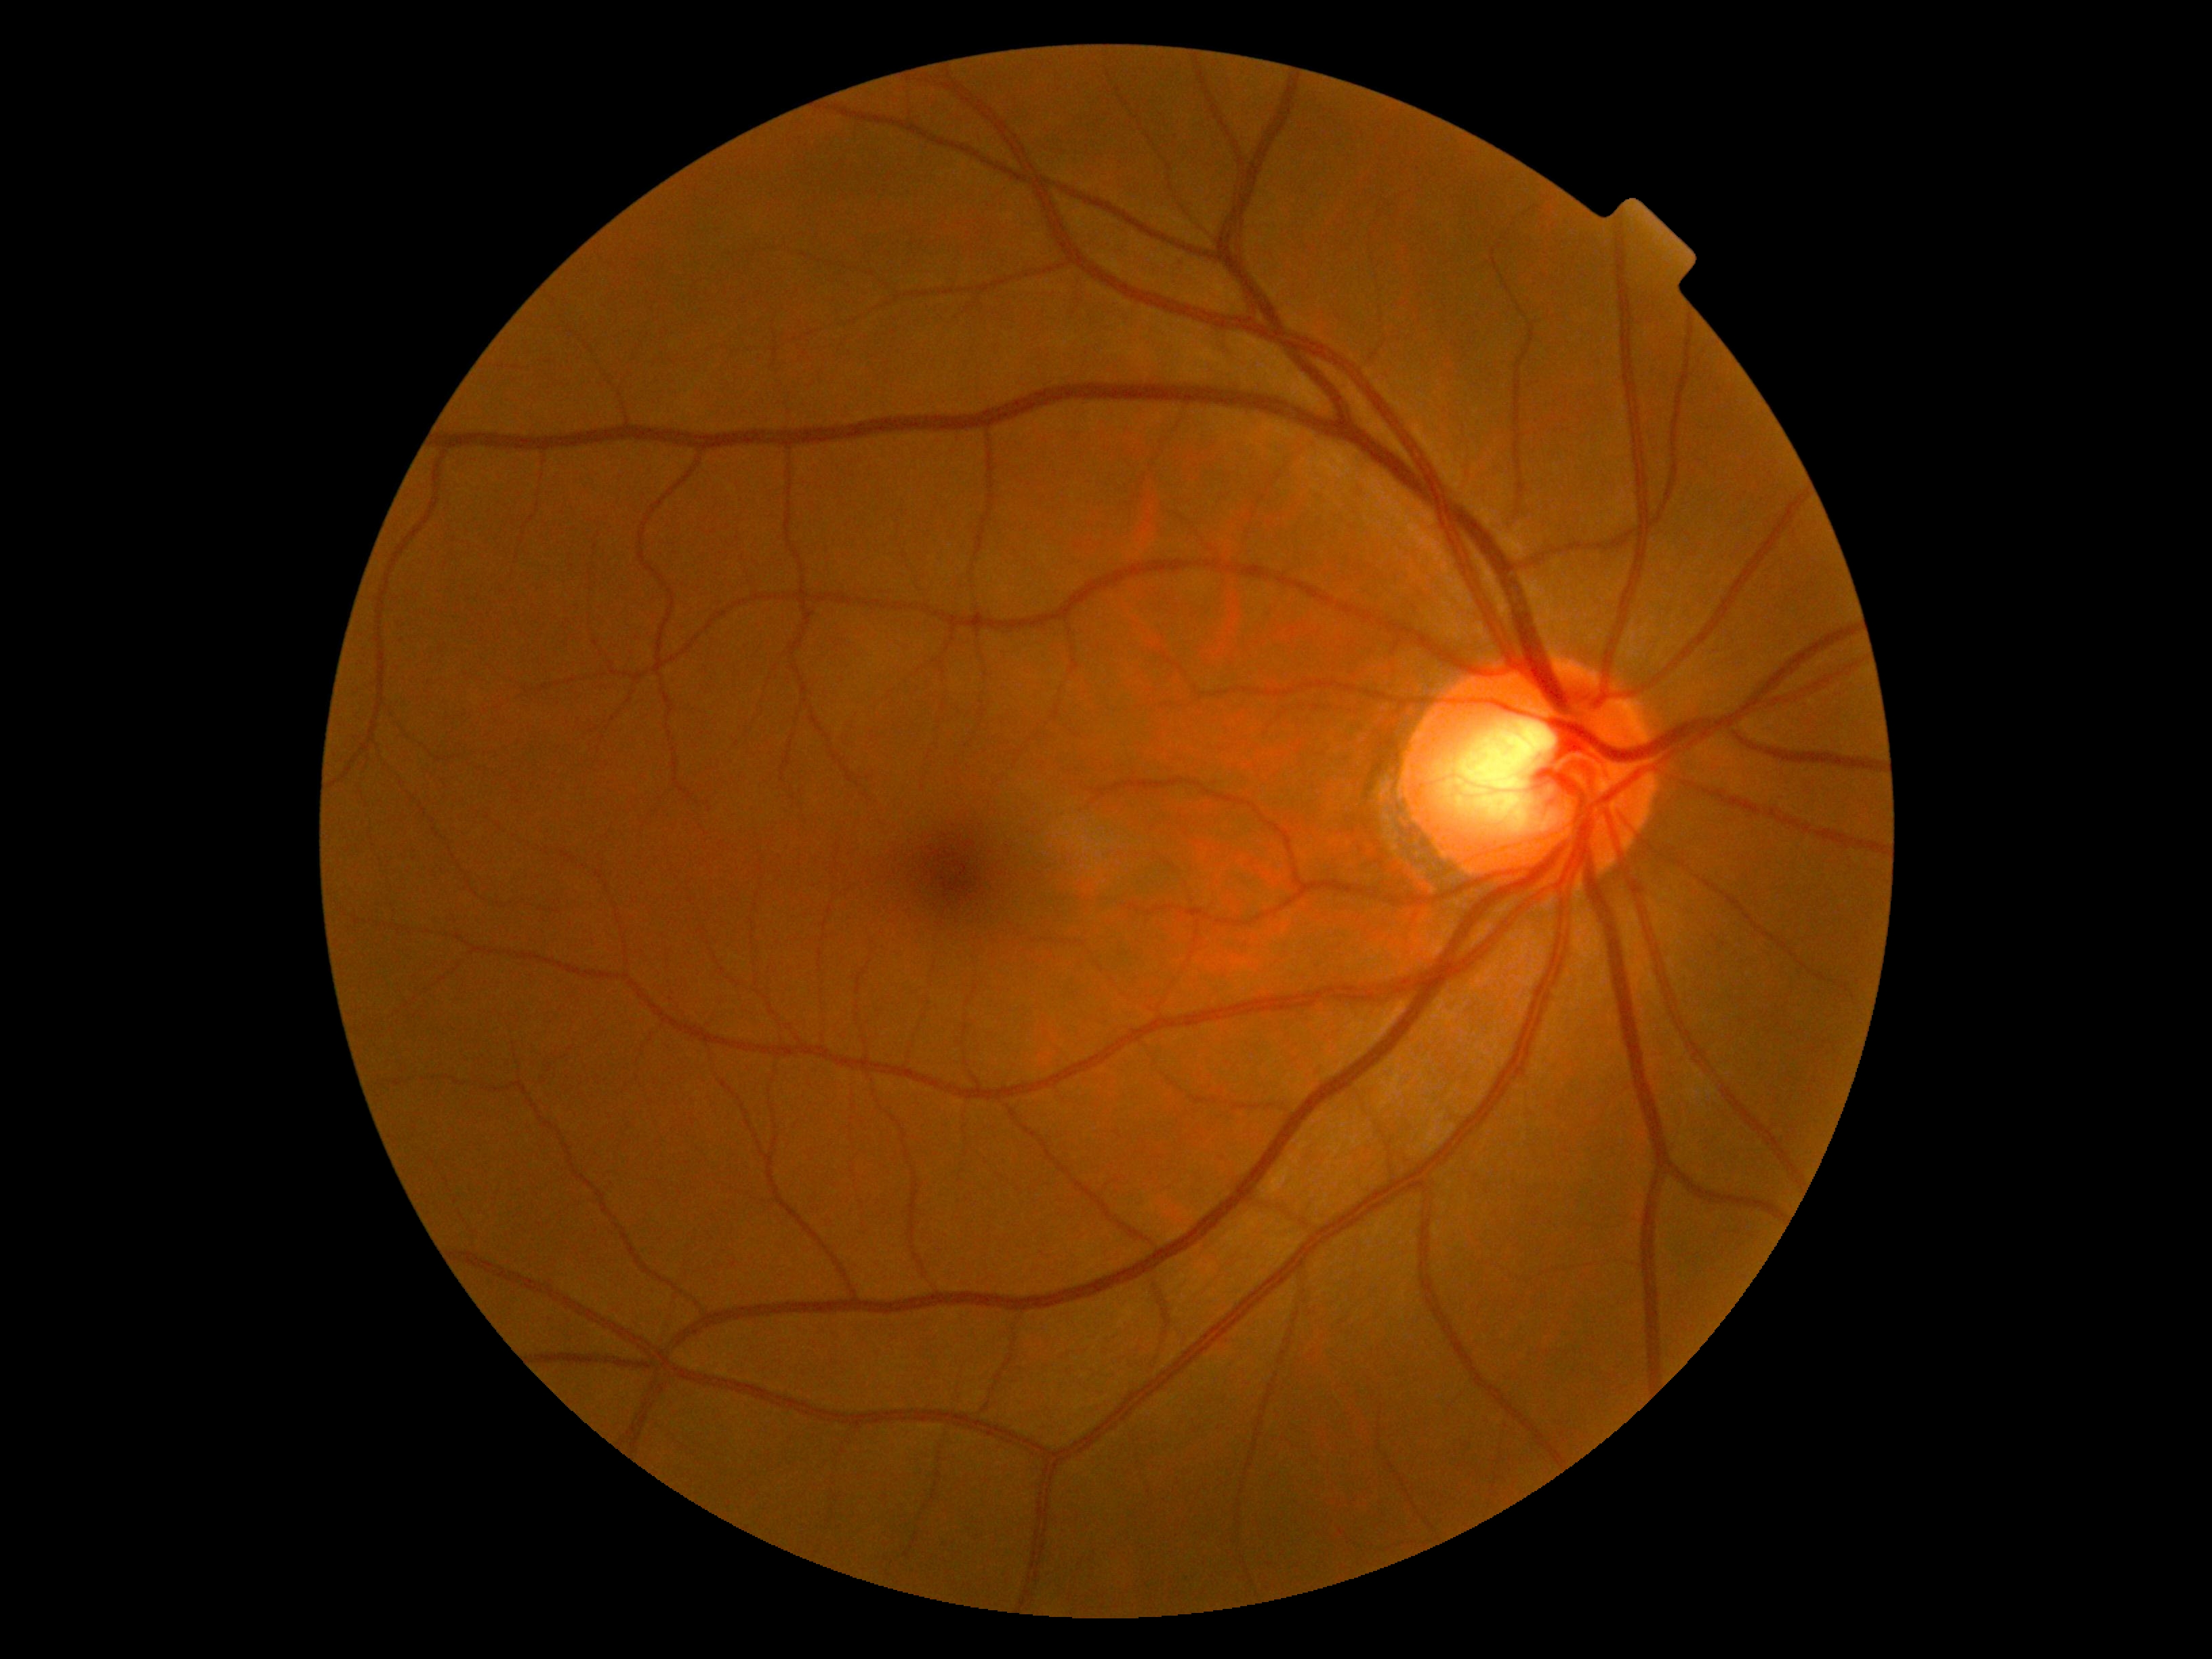

DR: grade 0 (no apparent retinopathy) — no visible signs of diabetic retinopathy.